Infant wide-field retinal image
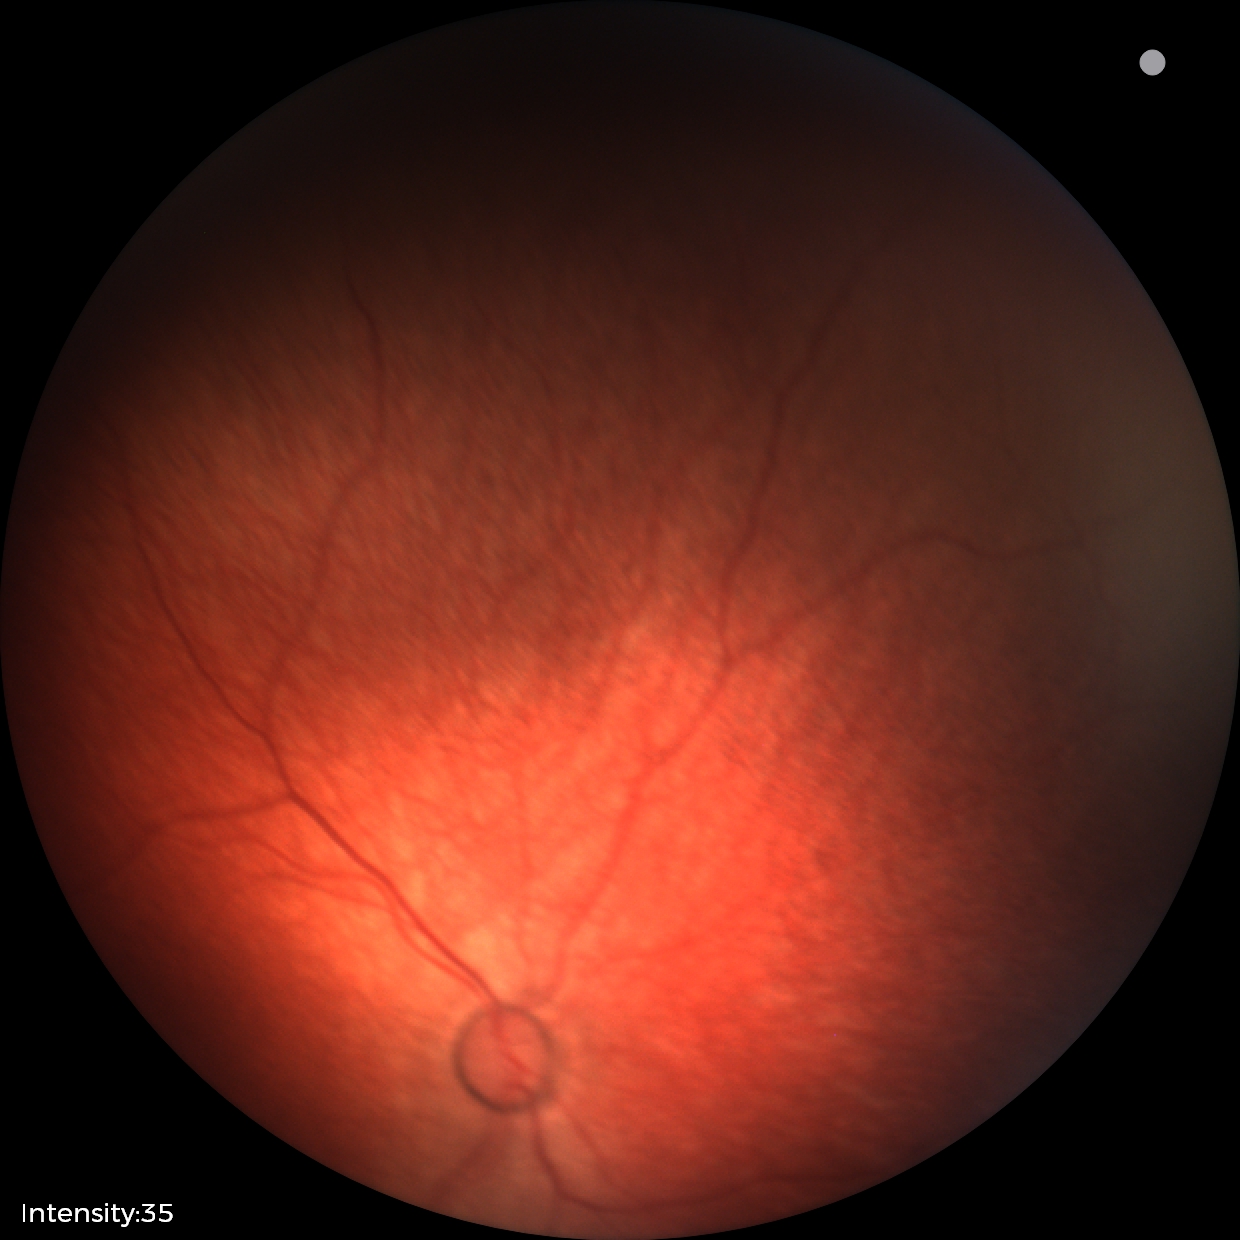 Physiological retinal appearance for postconceptual age.